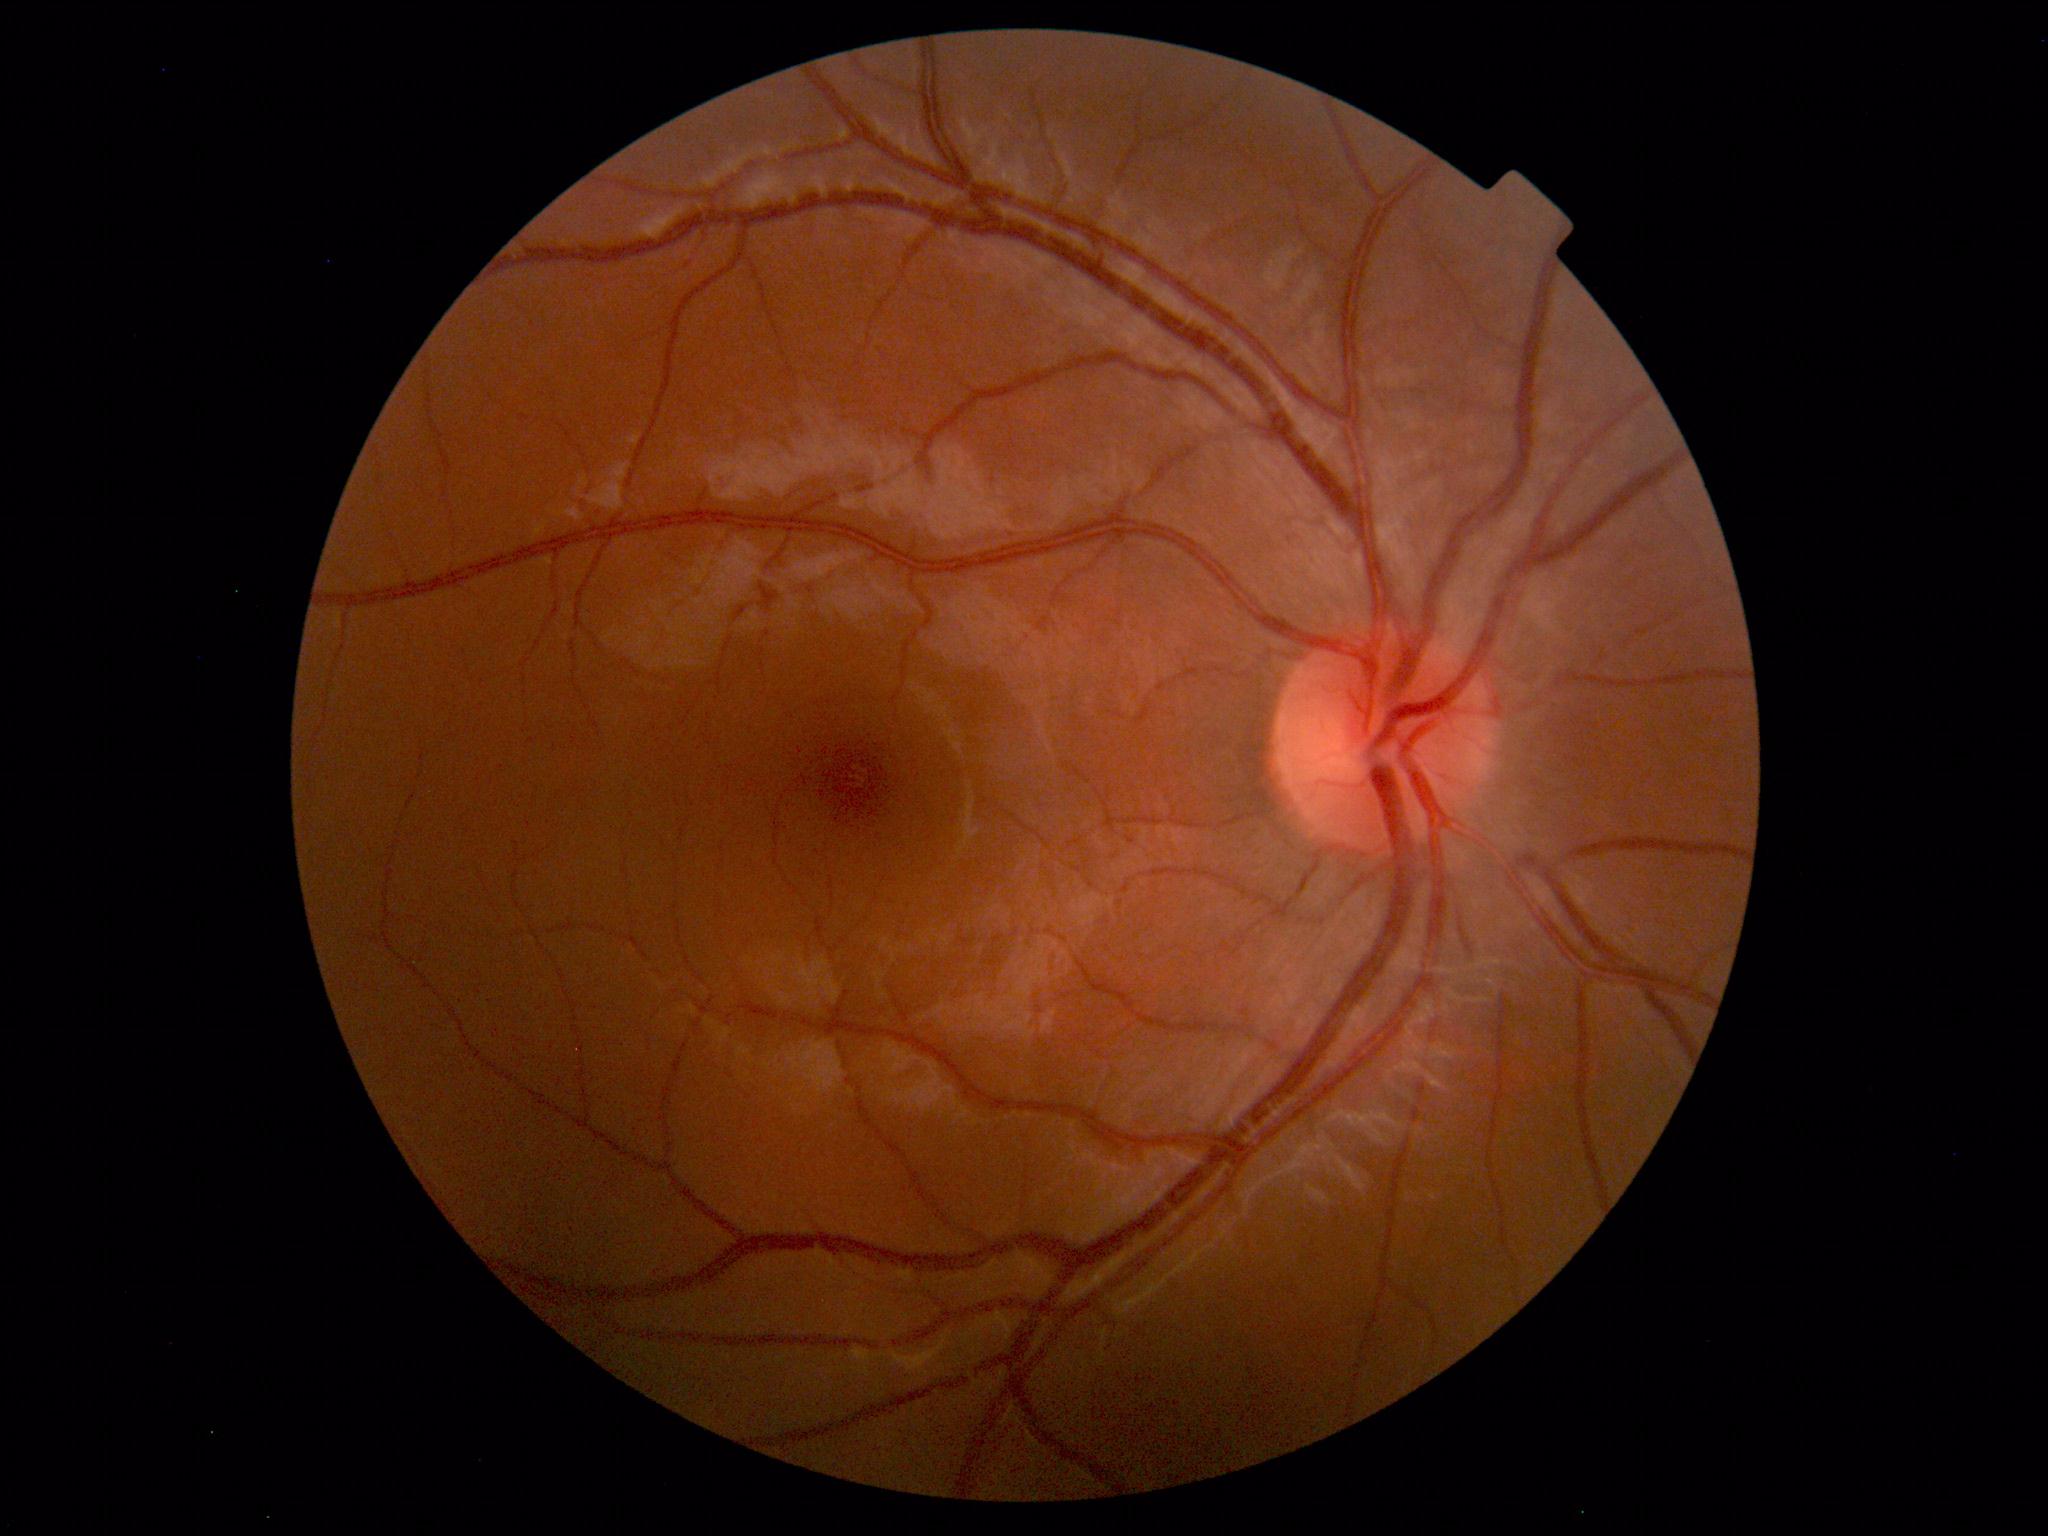 Findings: no abnormalities.